No pharmacologic dilation · graded on the modified Davis scale · image size 848x848 — 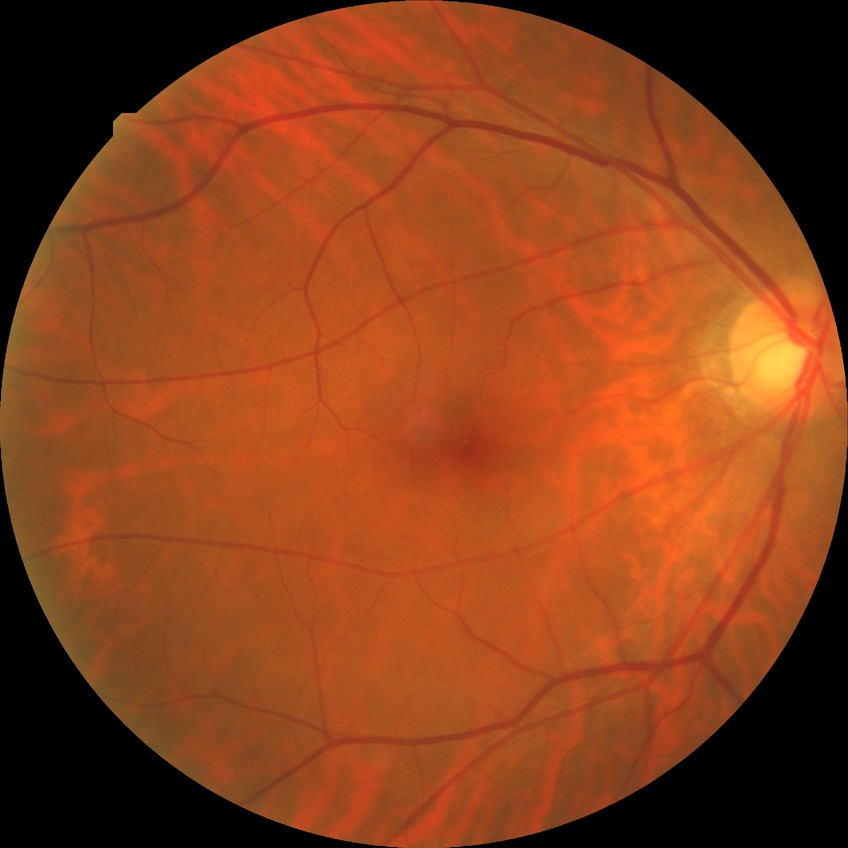 {
  "davis_grade": "NDR"
}